CFP; 1659 x 2212 pixels — 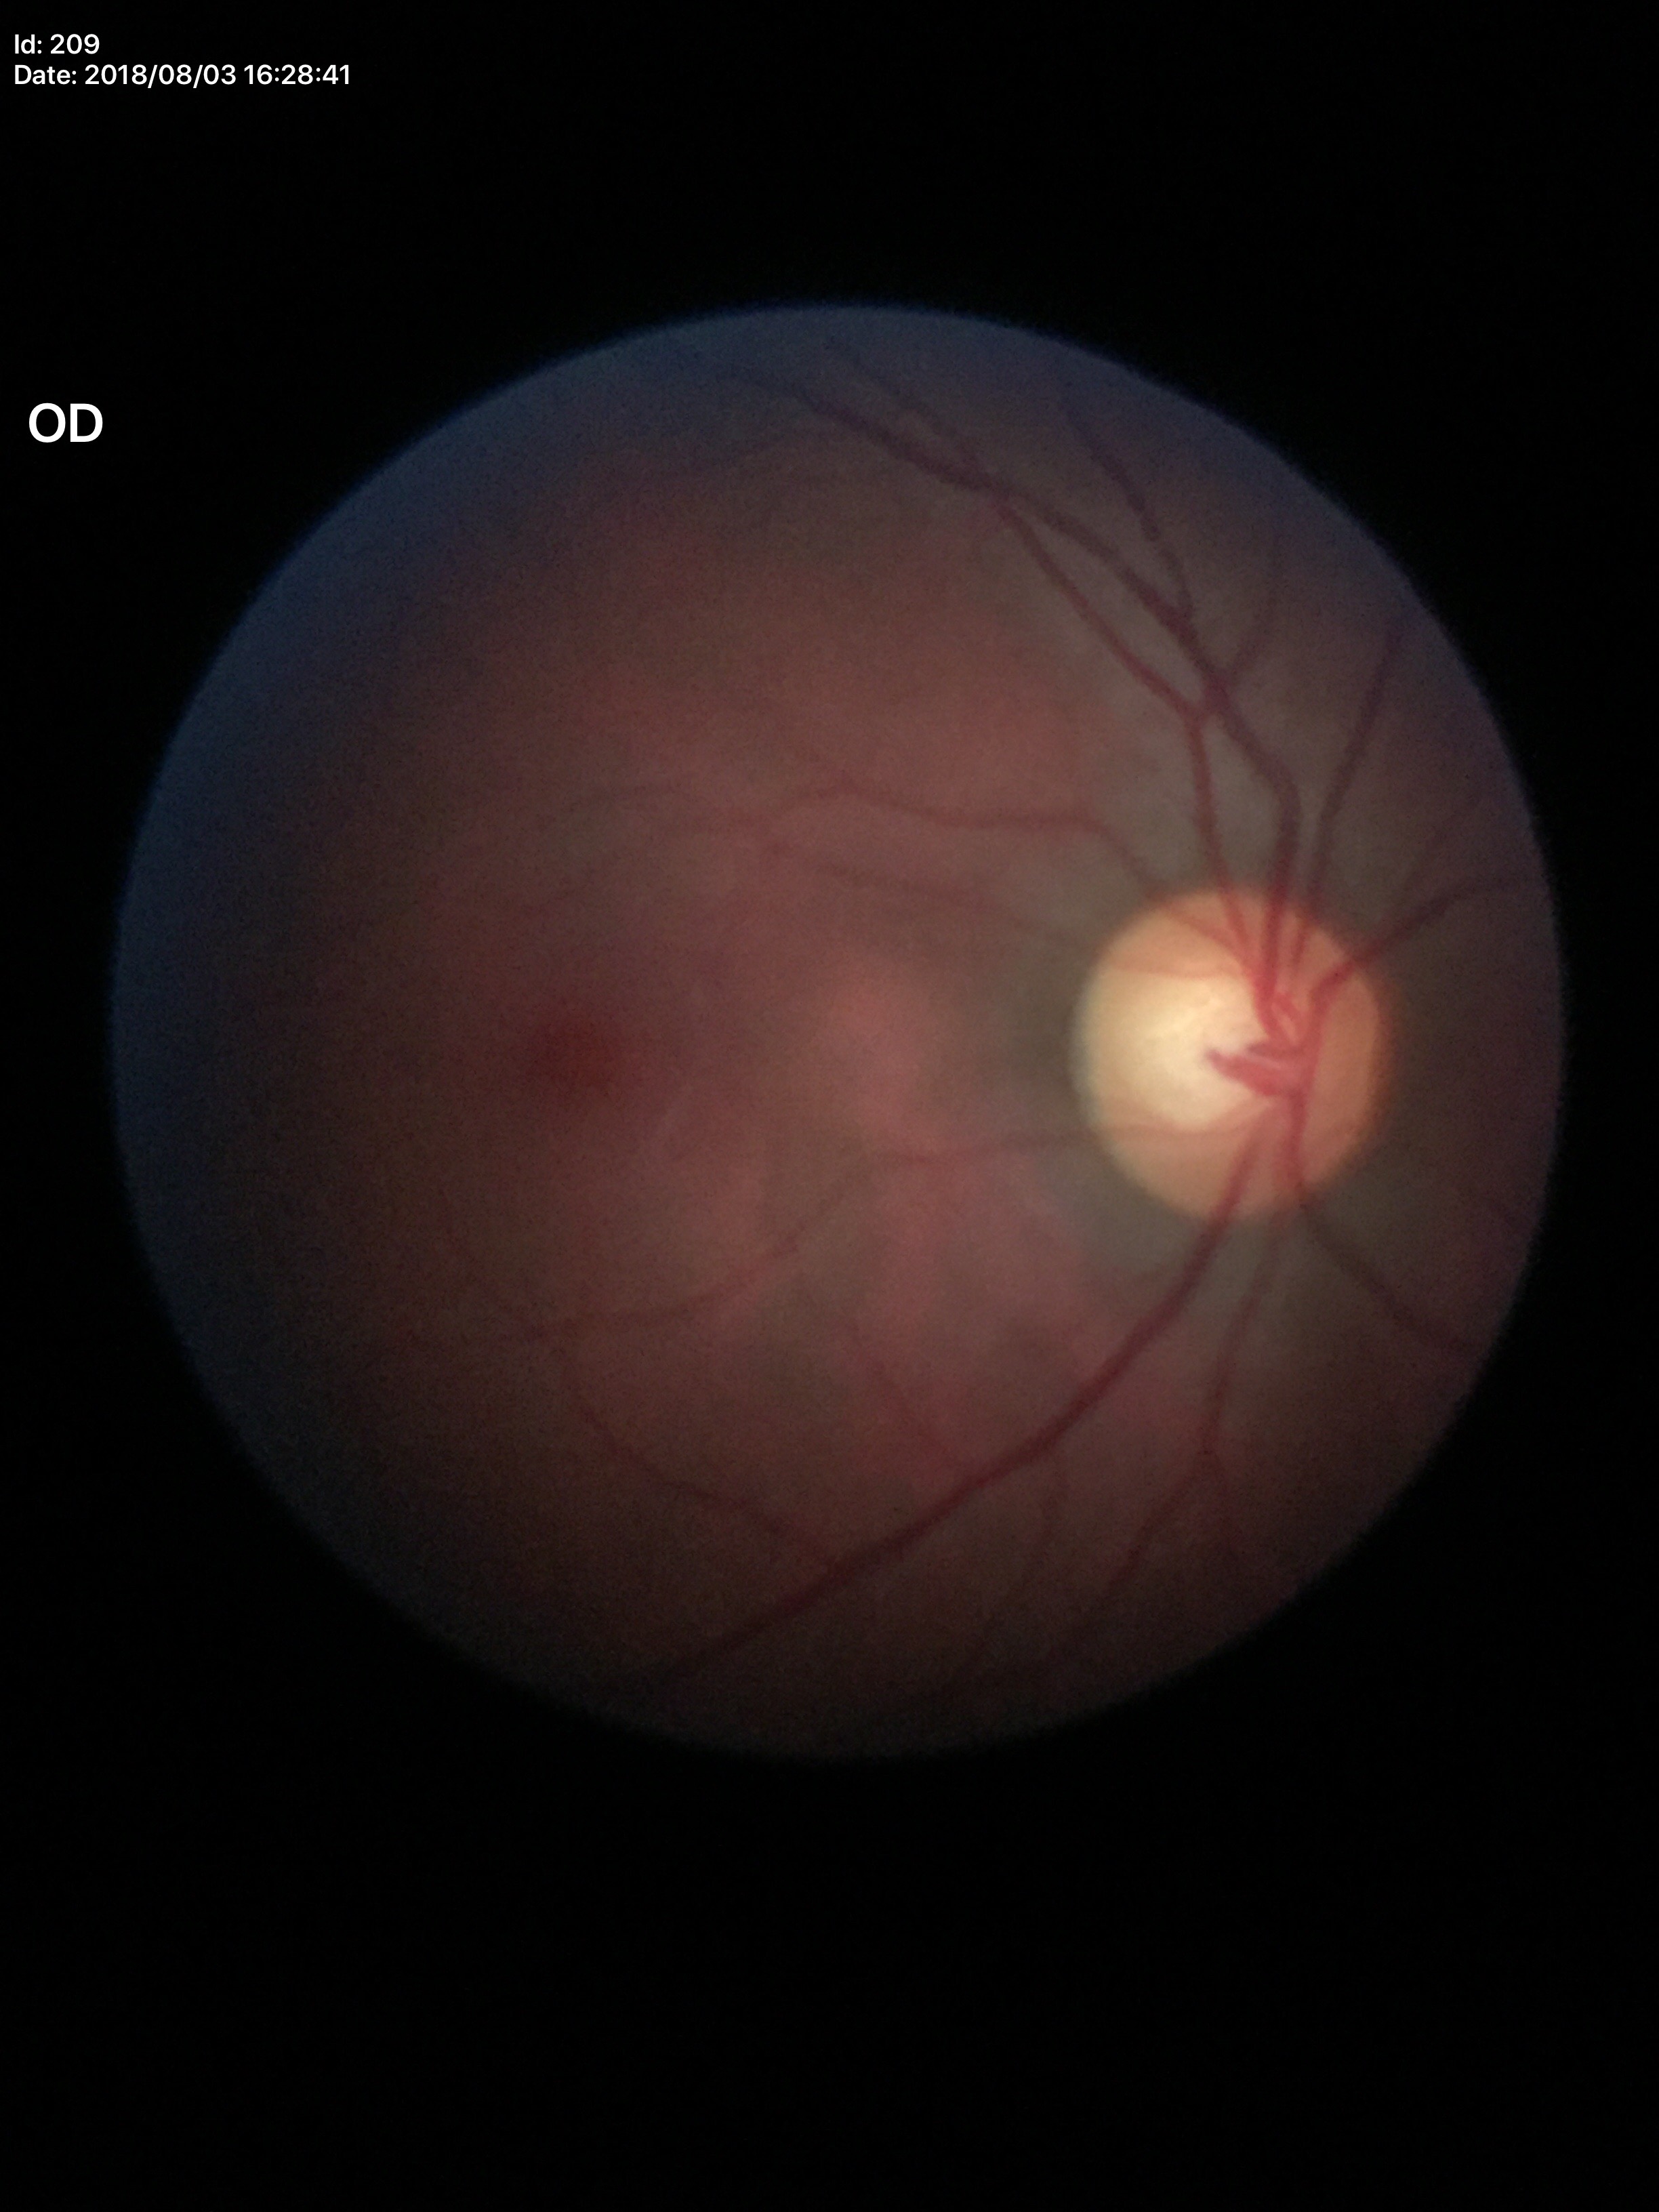

No glaucomatous findings.
Vertical C/D ratio (VCDR) is 0.55.